Image size 2352x1568 · fundus photo:
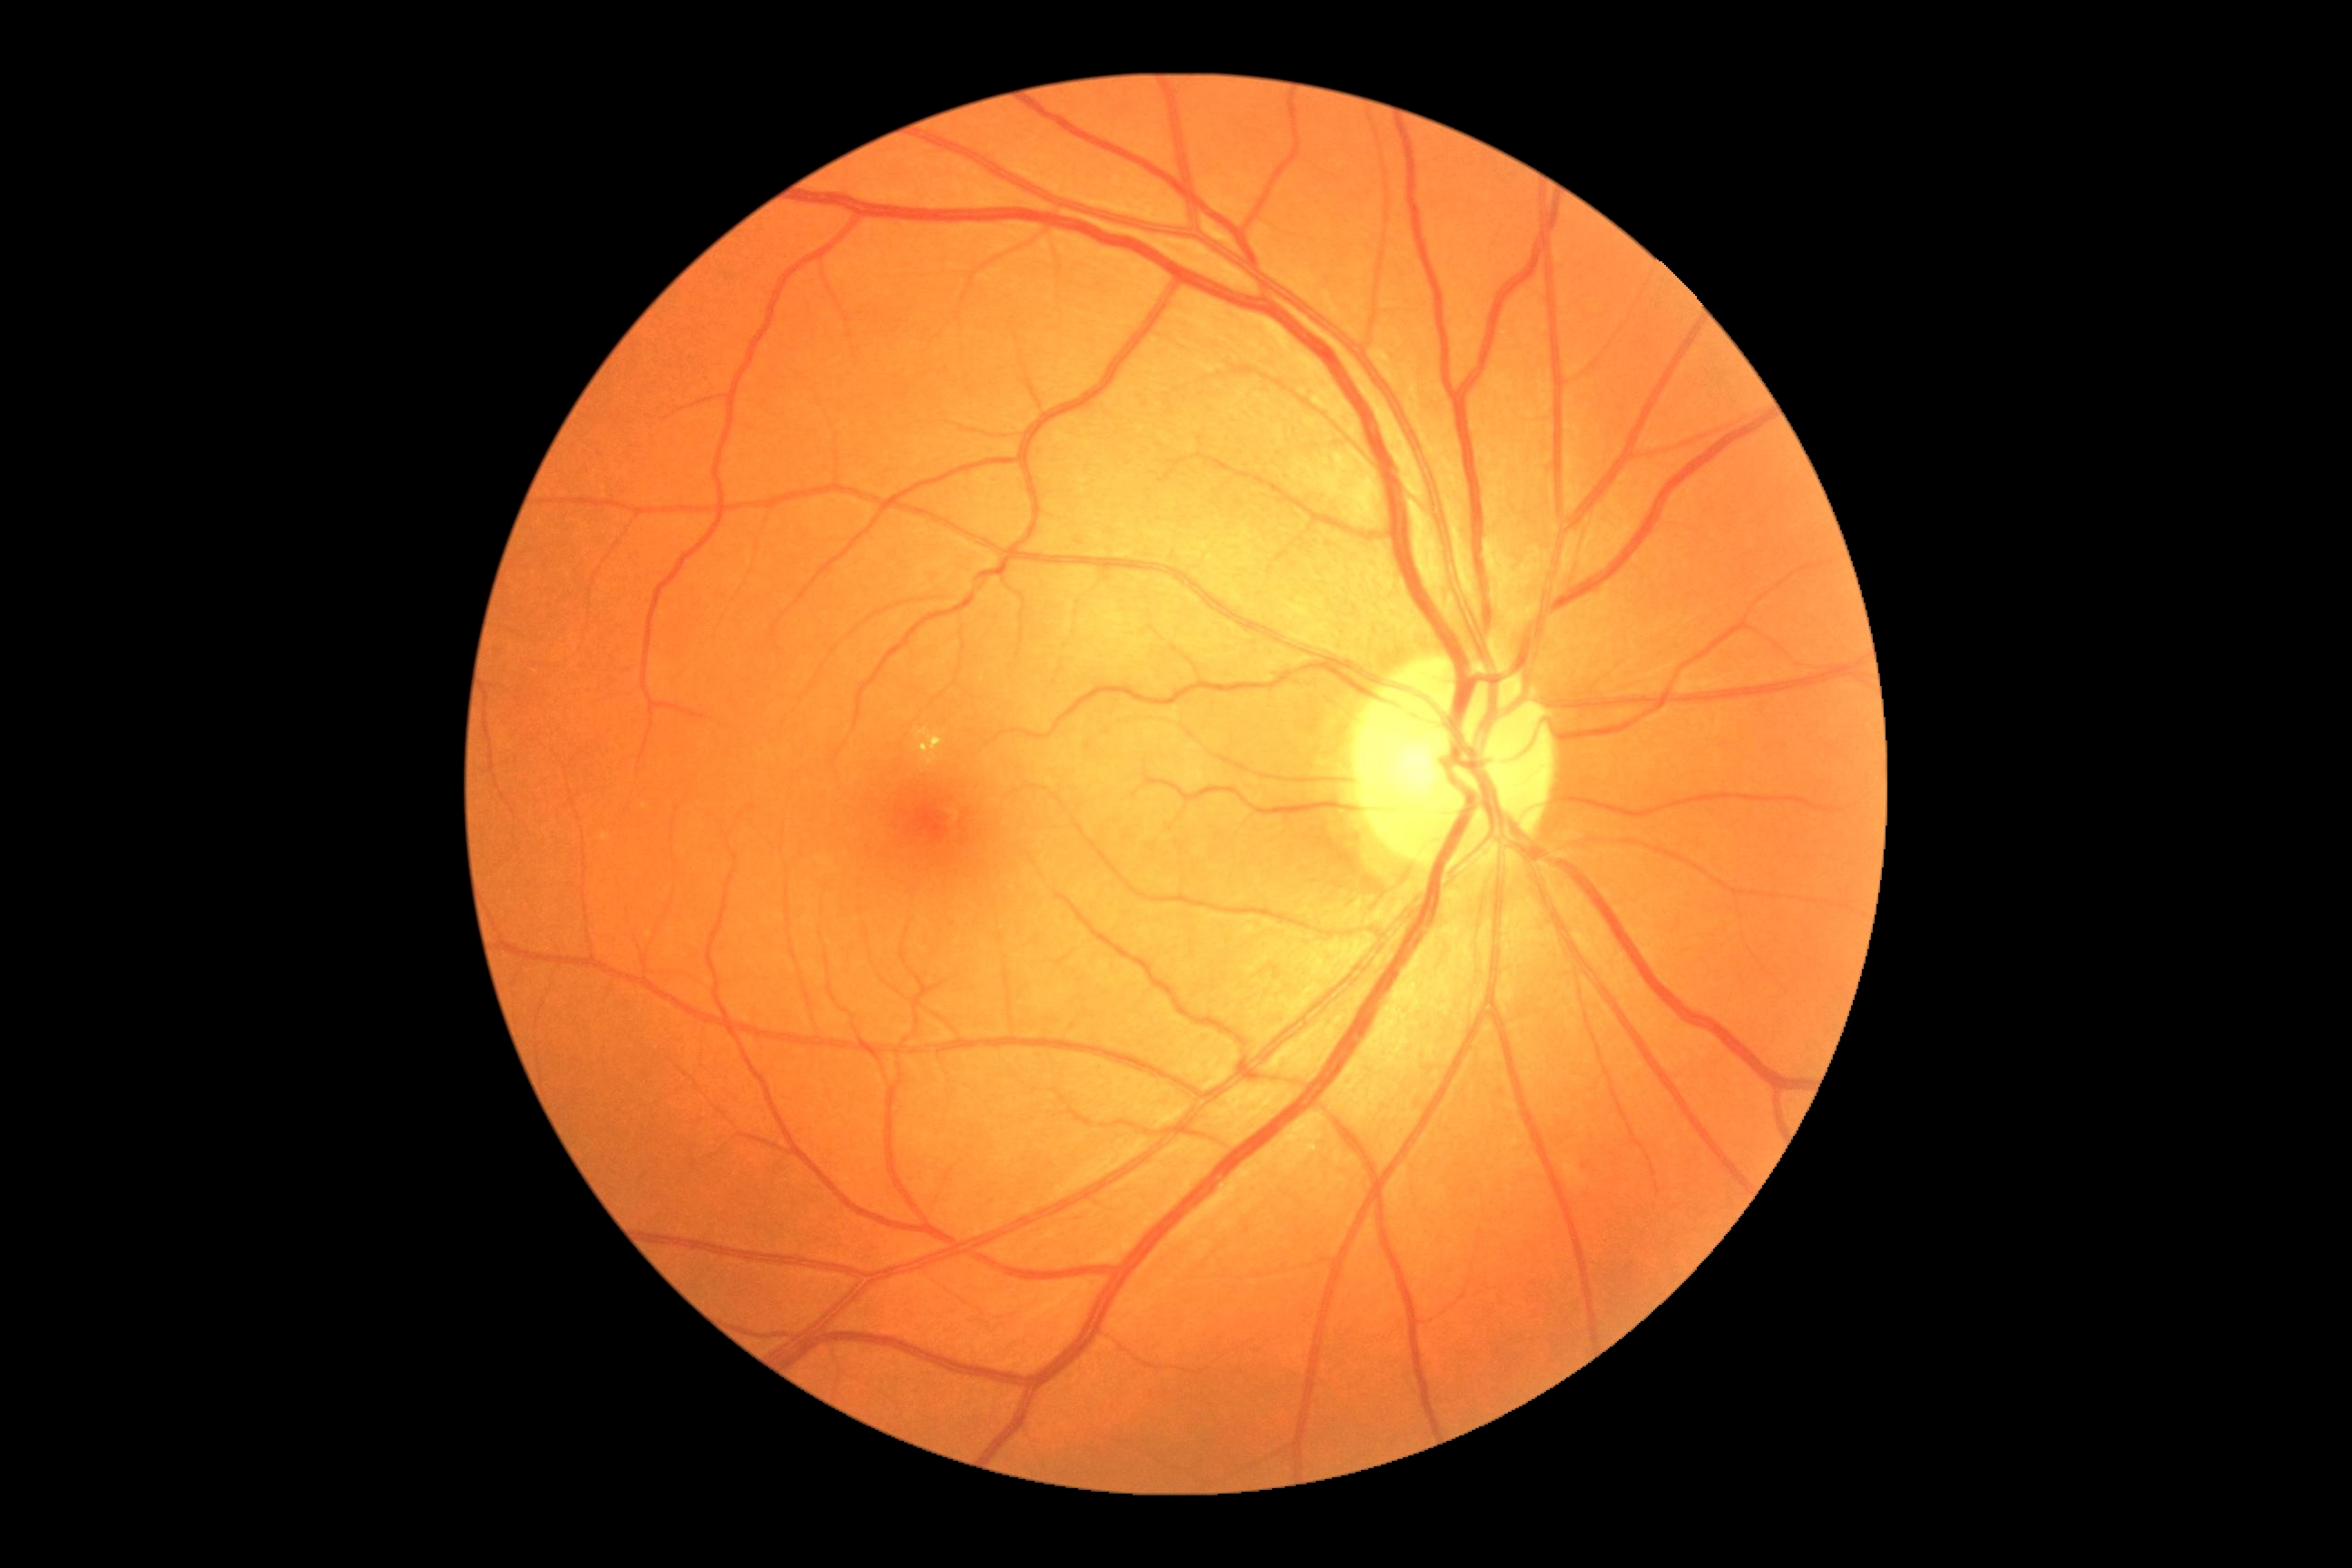

Diabetic retinopathy (DR): 2/4.